Camera: NIDEK AFC-230. Fundus photo.
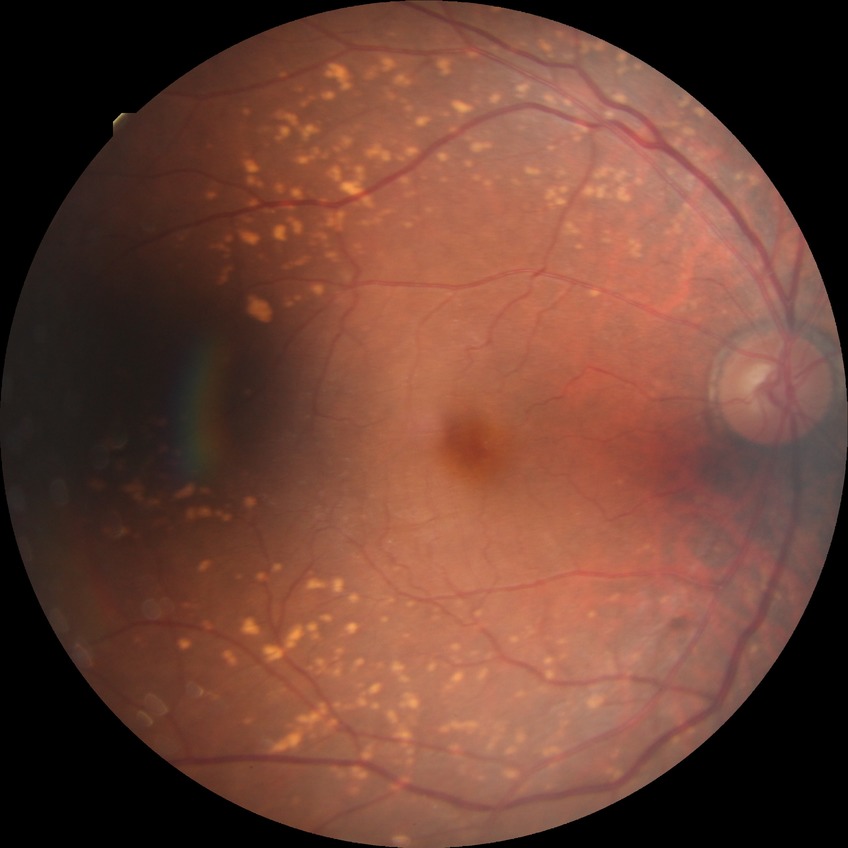
DR class: non-proliferative diabetic retinopathy. Diabetic retinopathy (DR): SDR (simple diabetic retinopathy).